848x848 · nonmydriatic fundus photograph · NIDEK AFC-230 fundus camera · CFP.
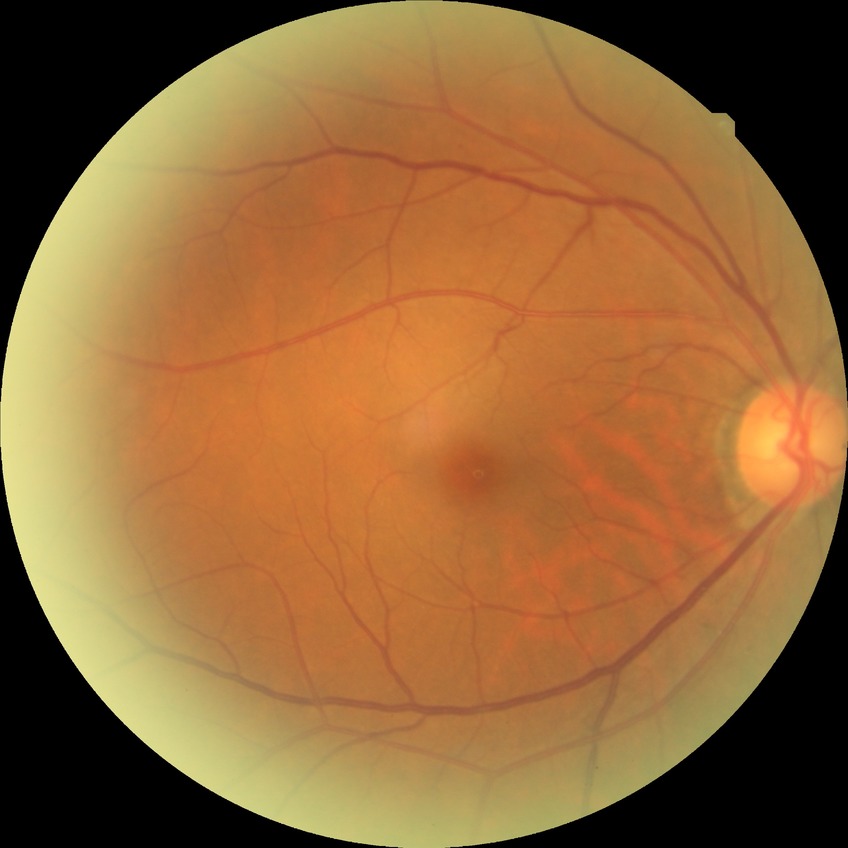

Modified Davis grading is no diabetic retinopathy.